1240 by 1240 pixels · infant wide-field retinal image: 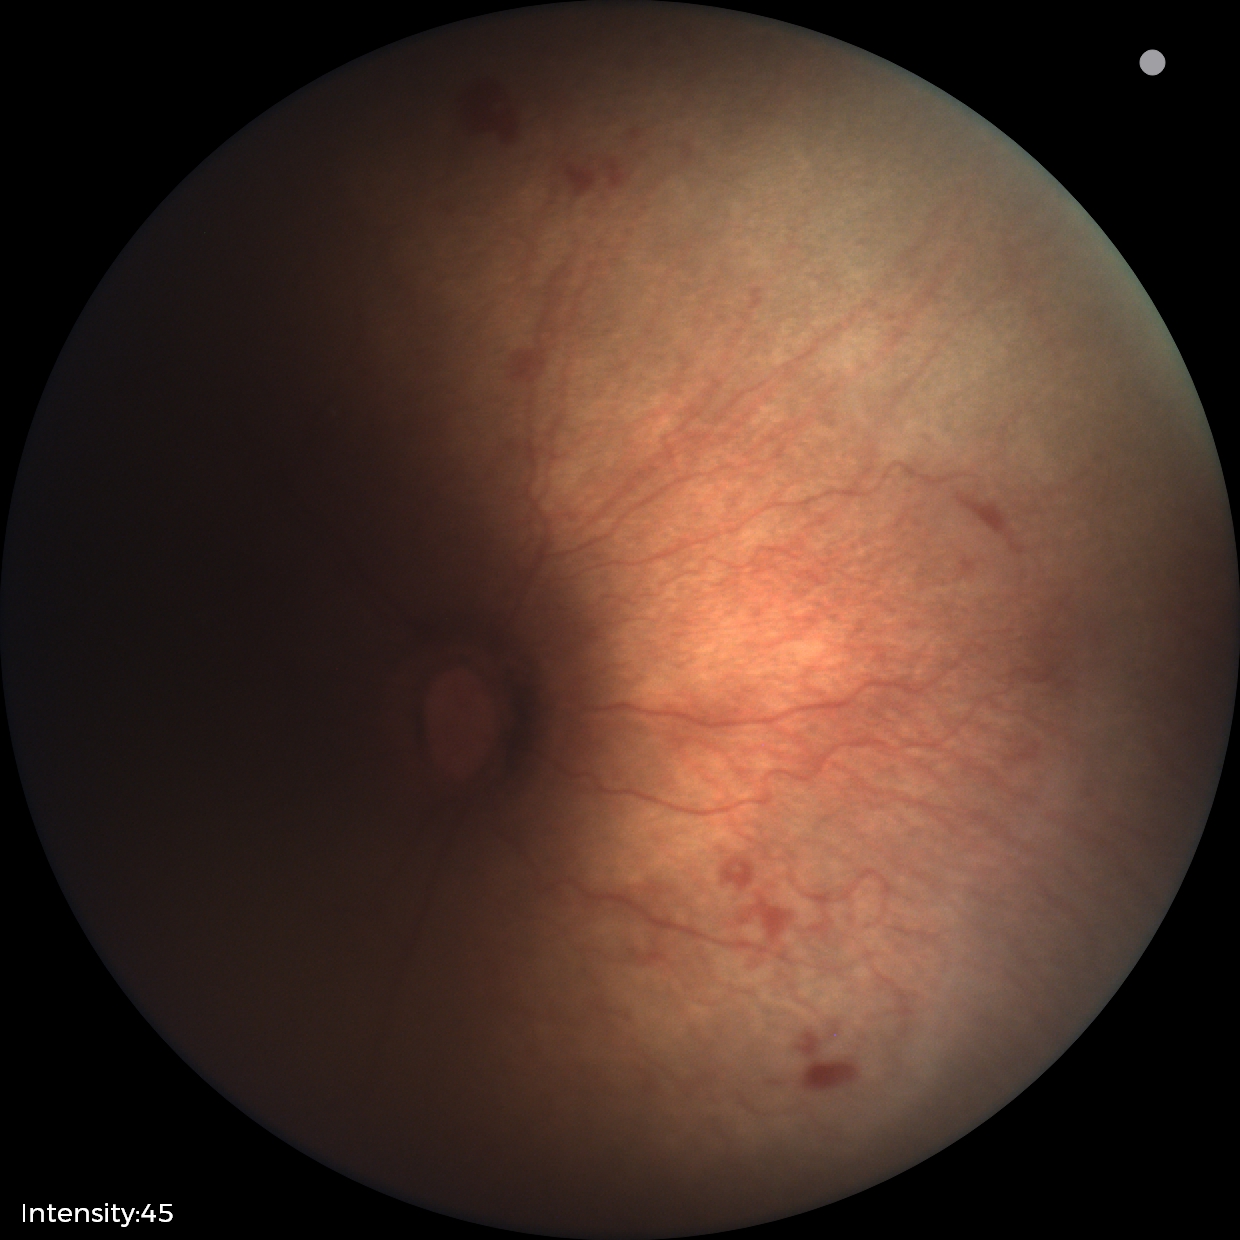

Impression: no plus disease; ROP stage 1.